240x240px
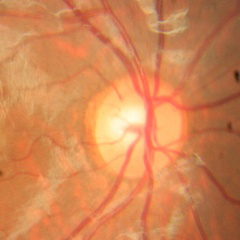

Glaucoma assessment = no glaucomatous findings.